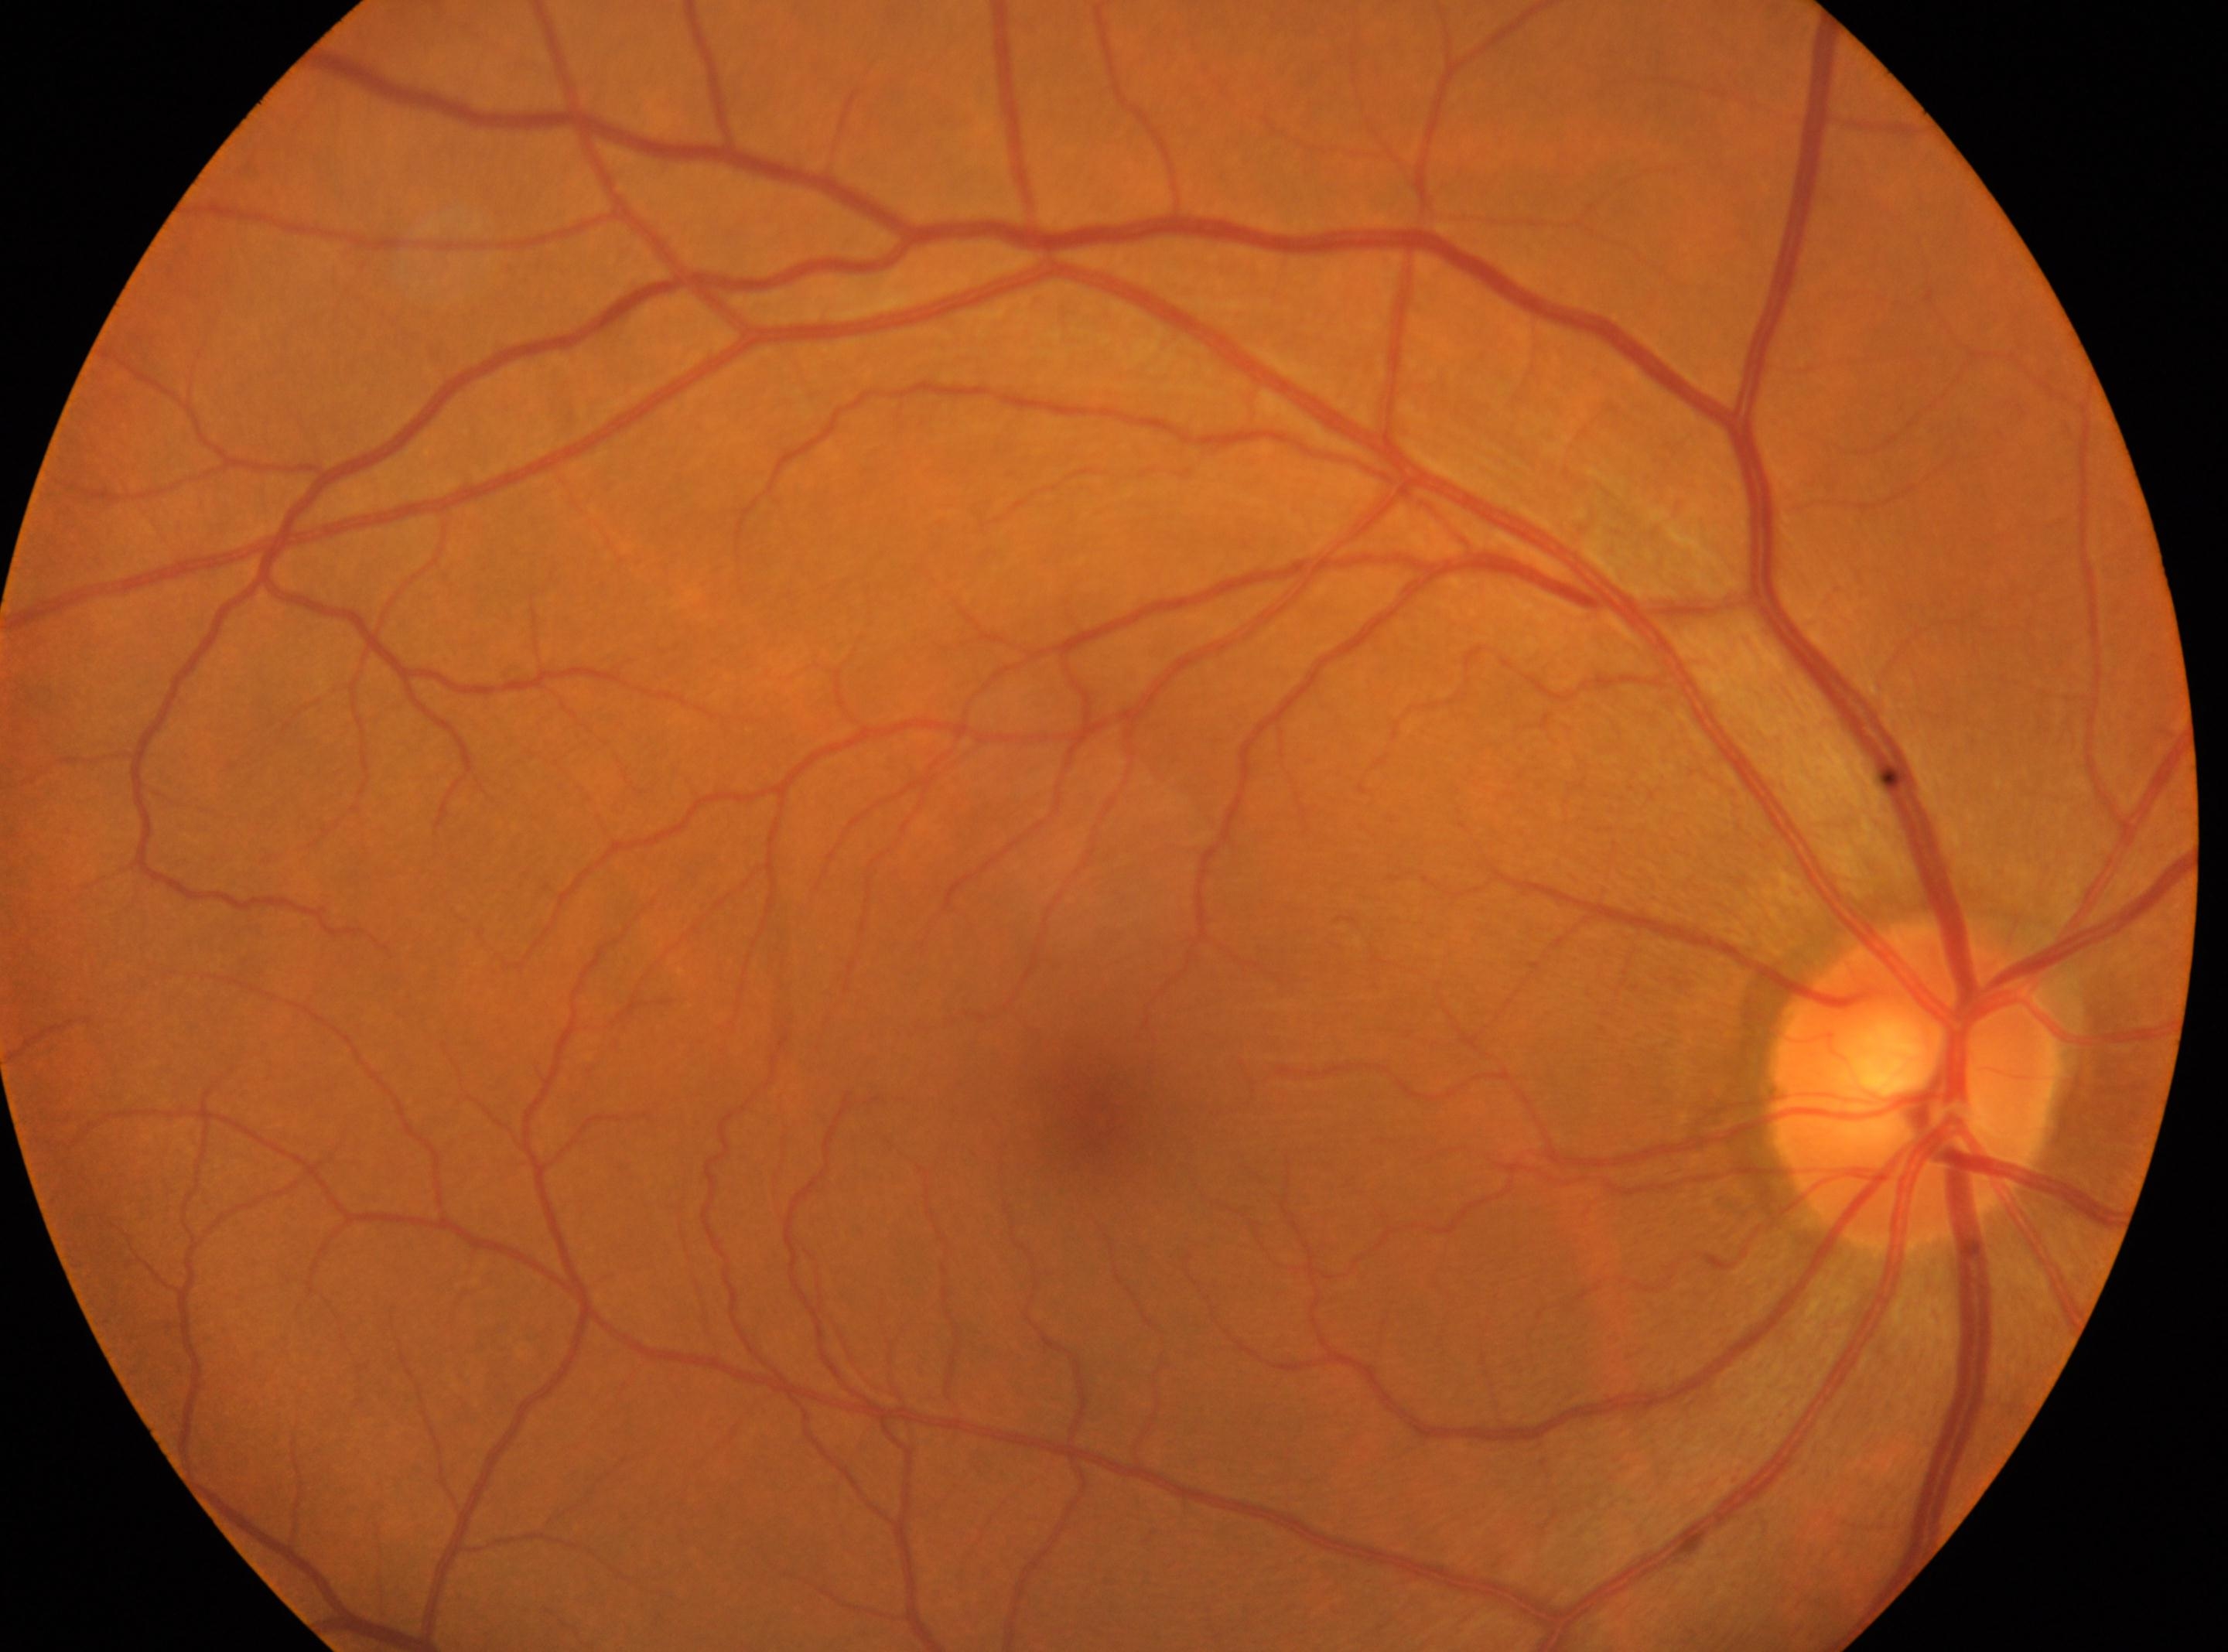

Fovea center located at (x=1092, y=1120). Retinopathy grade is 0/4. ONH located at (x=1914, y=1086). Eye: OD.